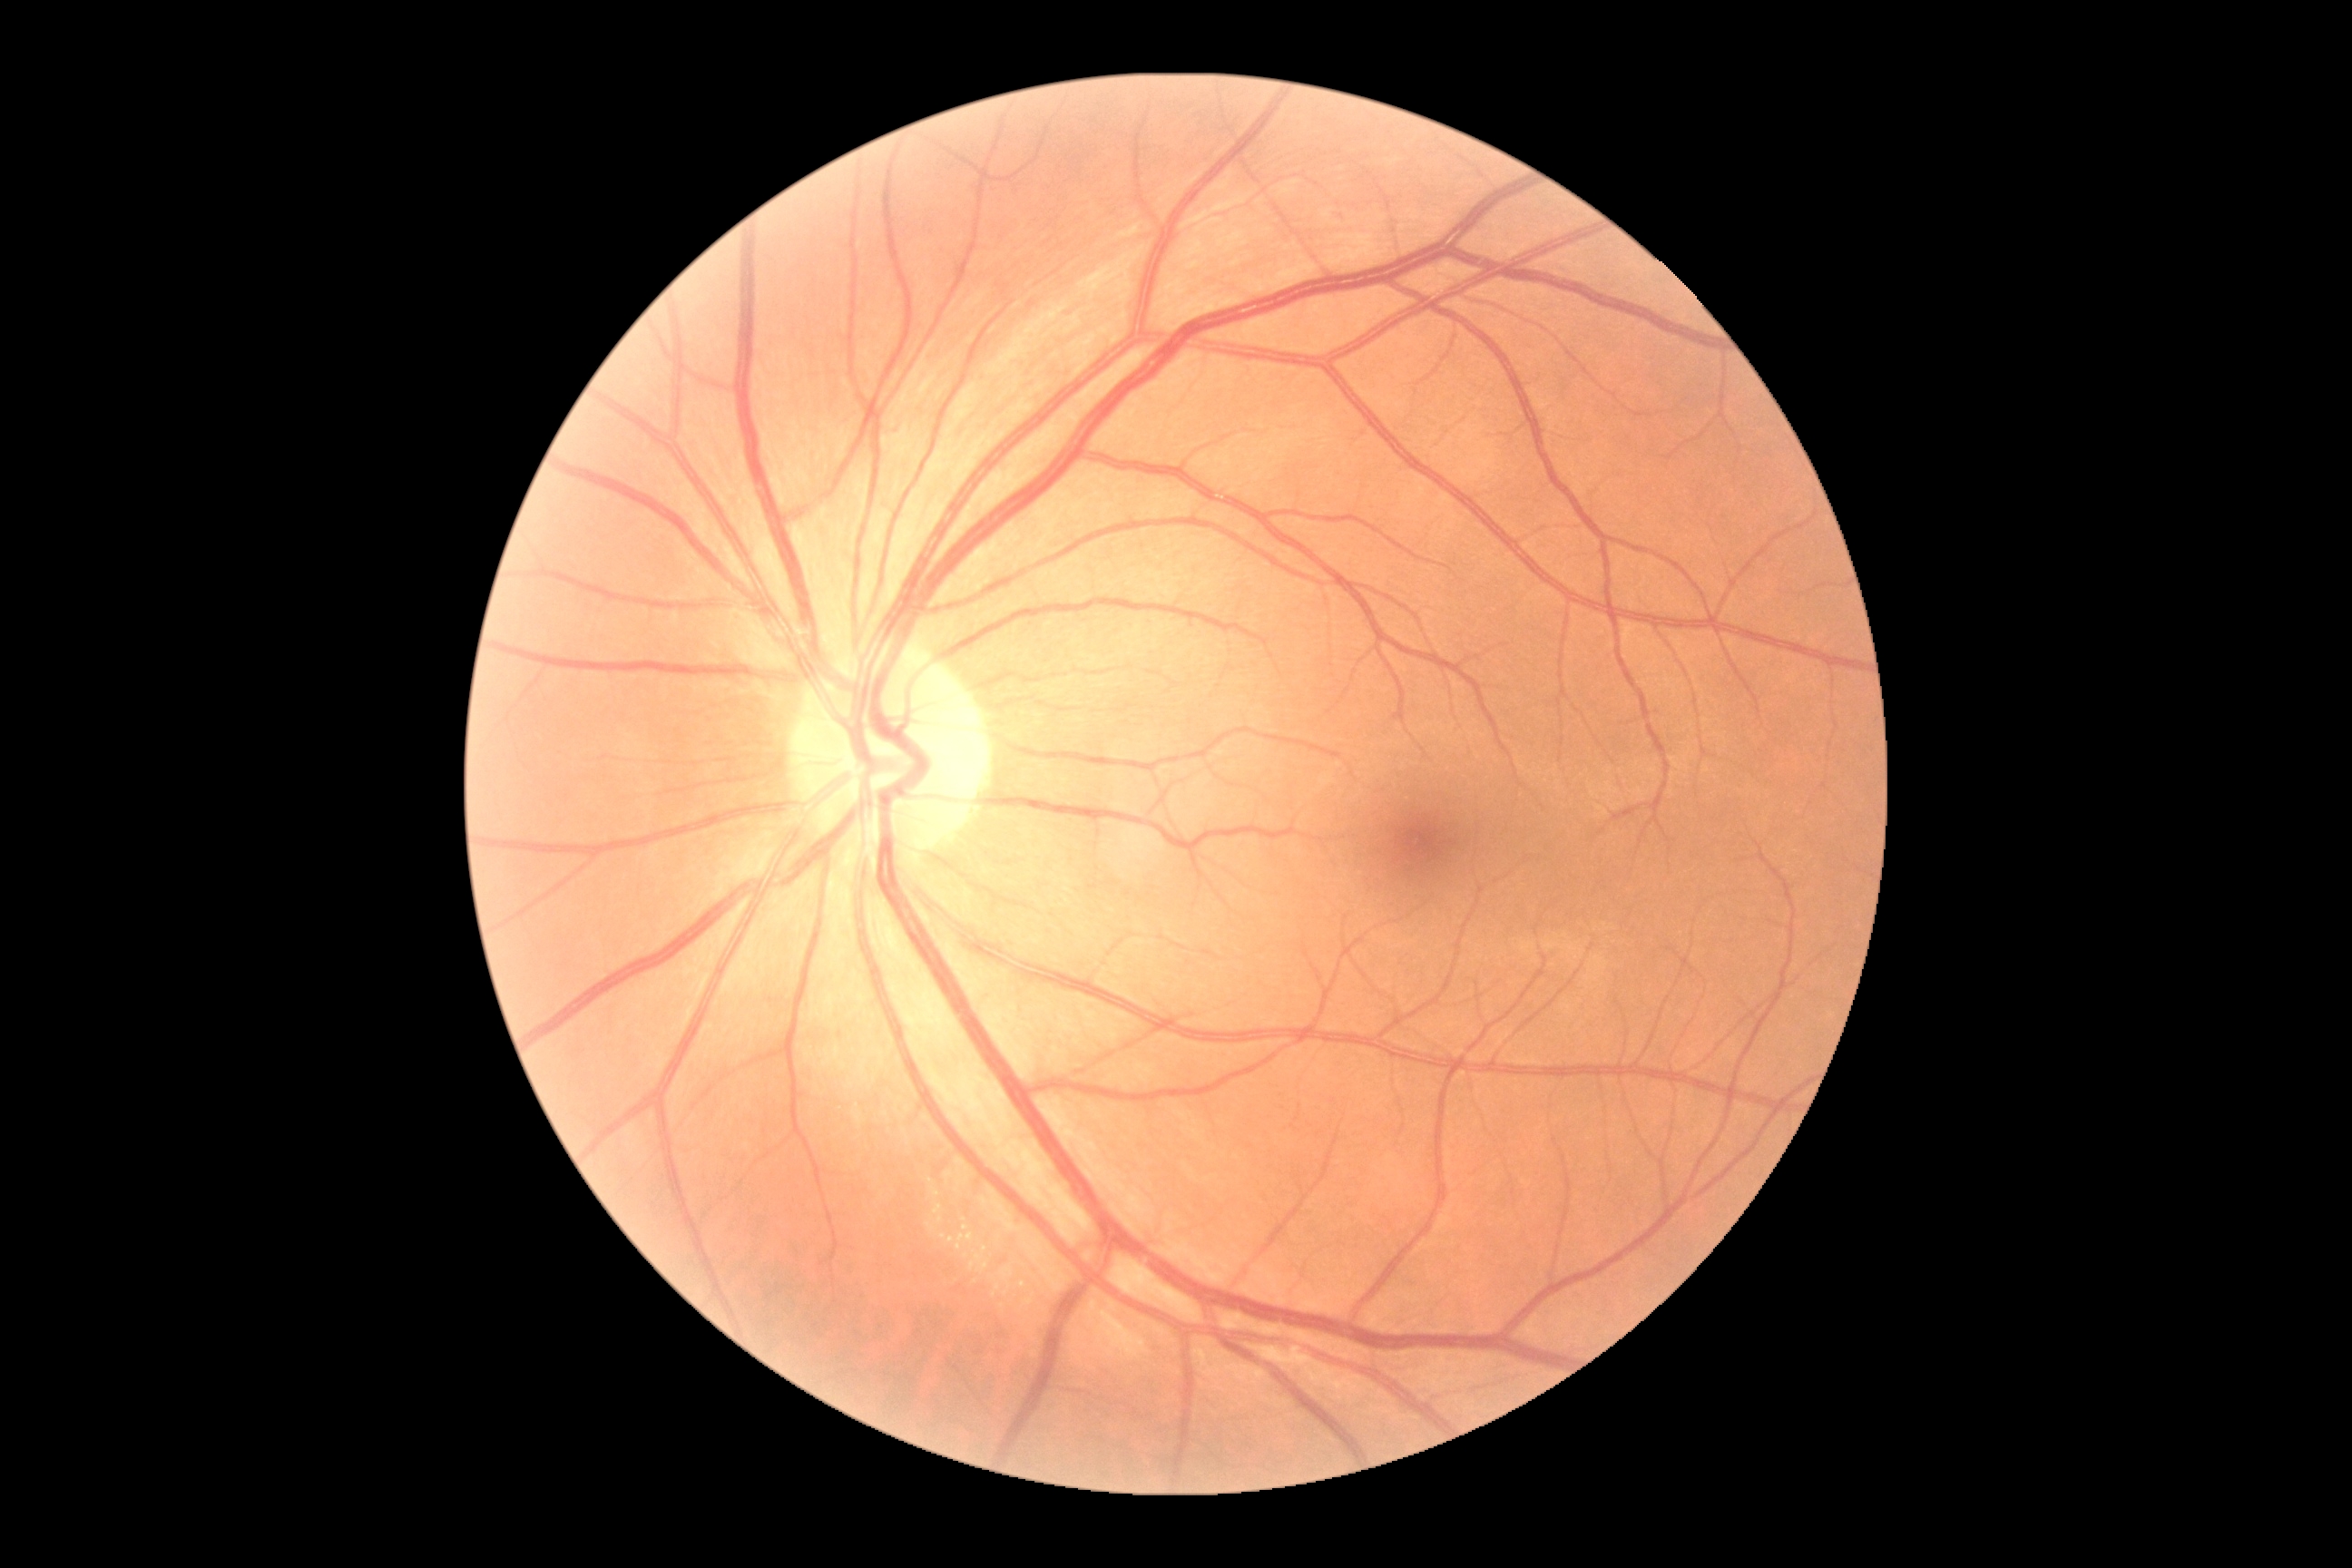

Retinopathy grade is 0 (no apparent retinopathy).